848 x 848 pixels, without pupil dilation, camera: NIDEK AFC-230 — 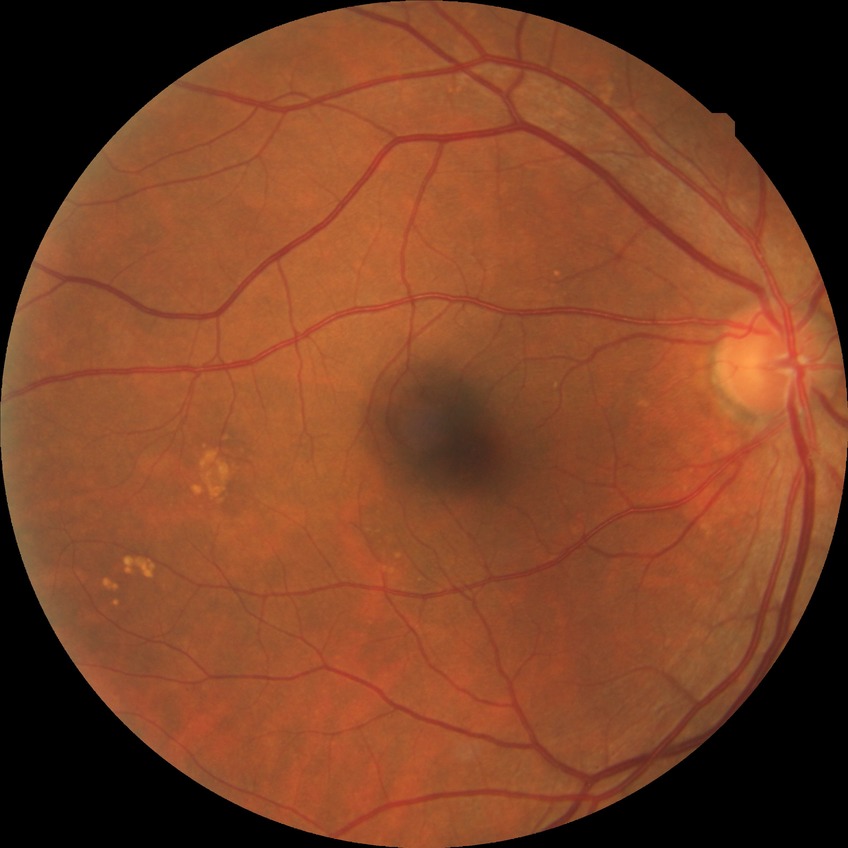 Diabetic retinopathy (DR): NDR (no diabetic retinopathy).